848 x 848 pixels; posterior pole color fundus photograph.
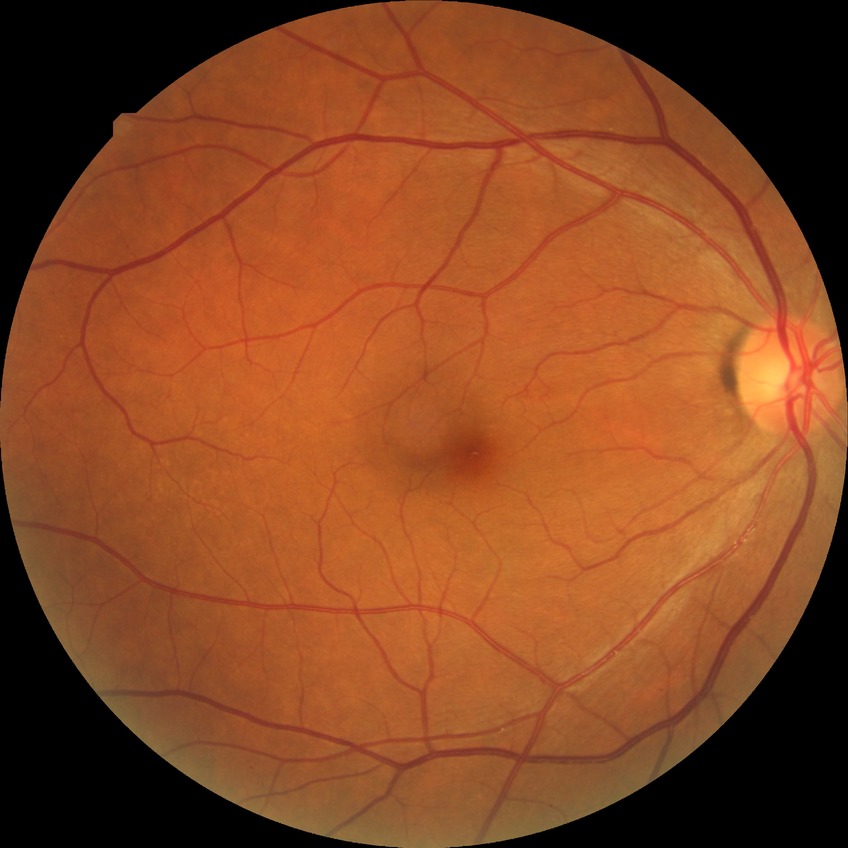
No DR findings. DR grade: NDR.